Acquired with a NIDEK AFC-230 — 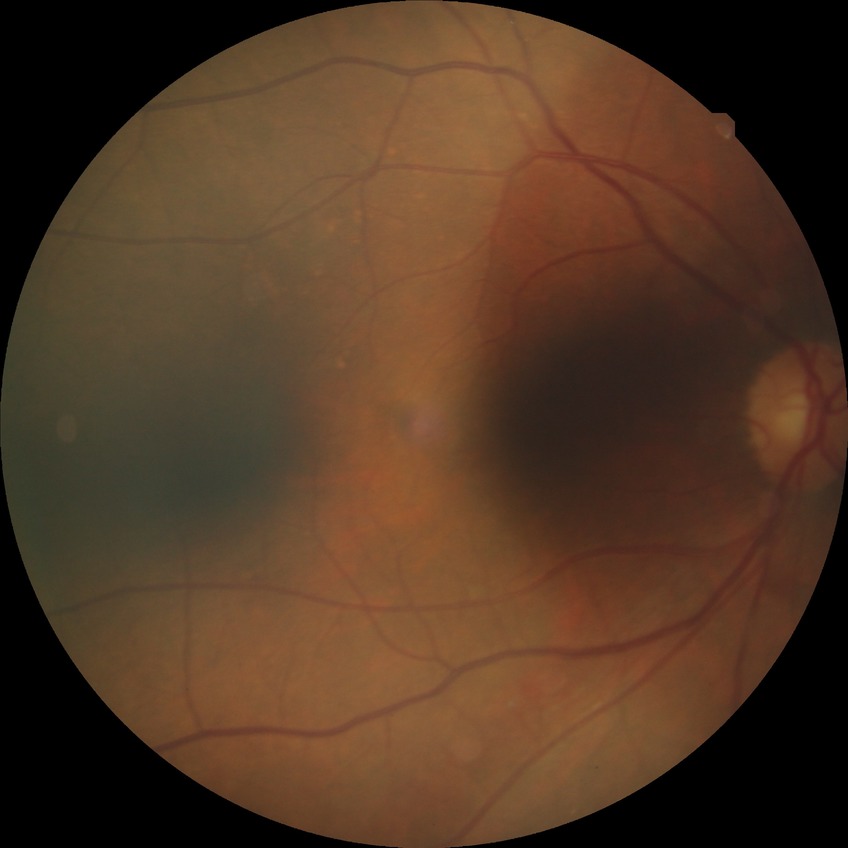 Davis grade is NDR.